CFP
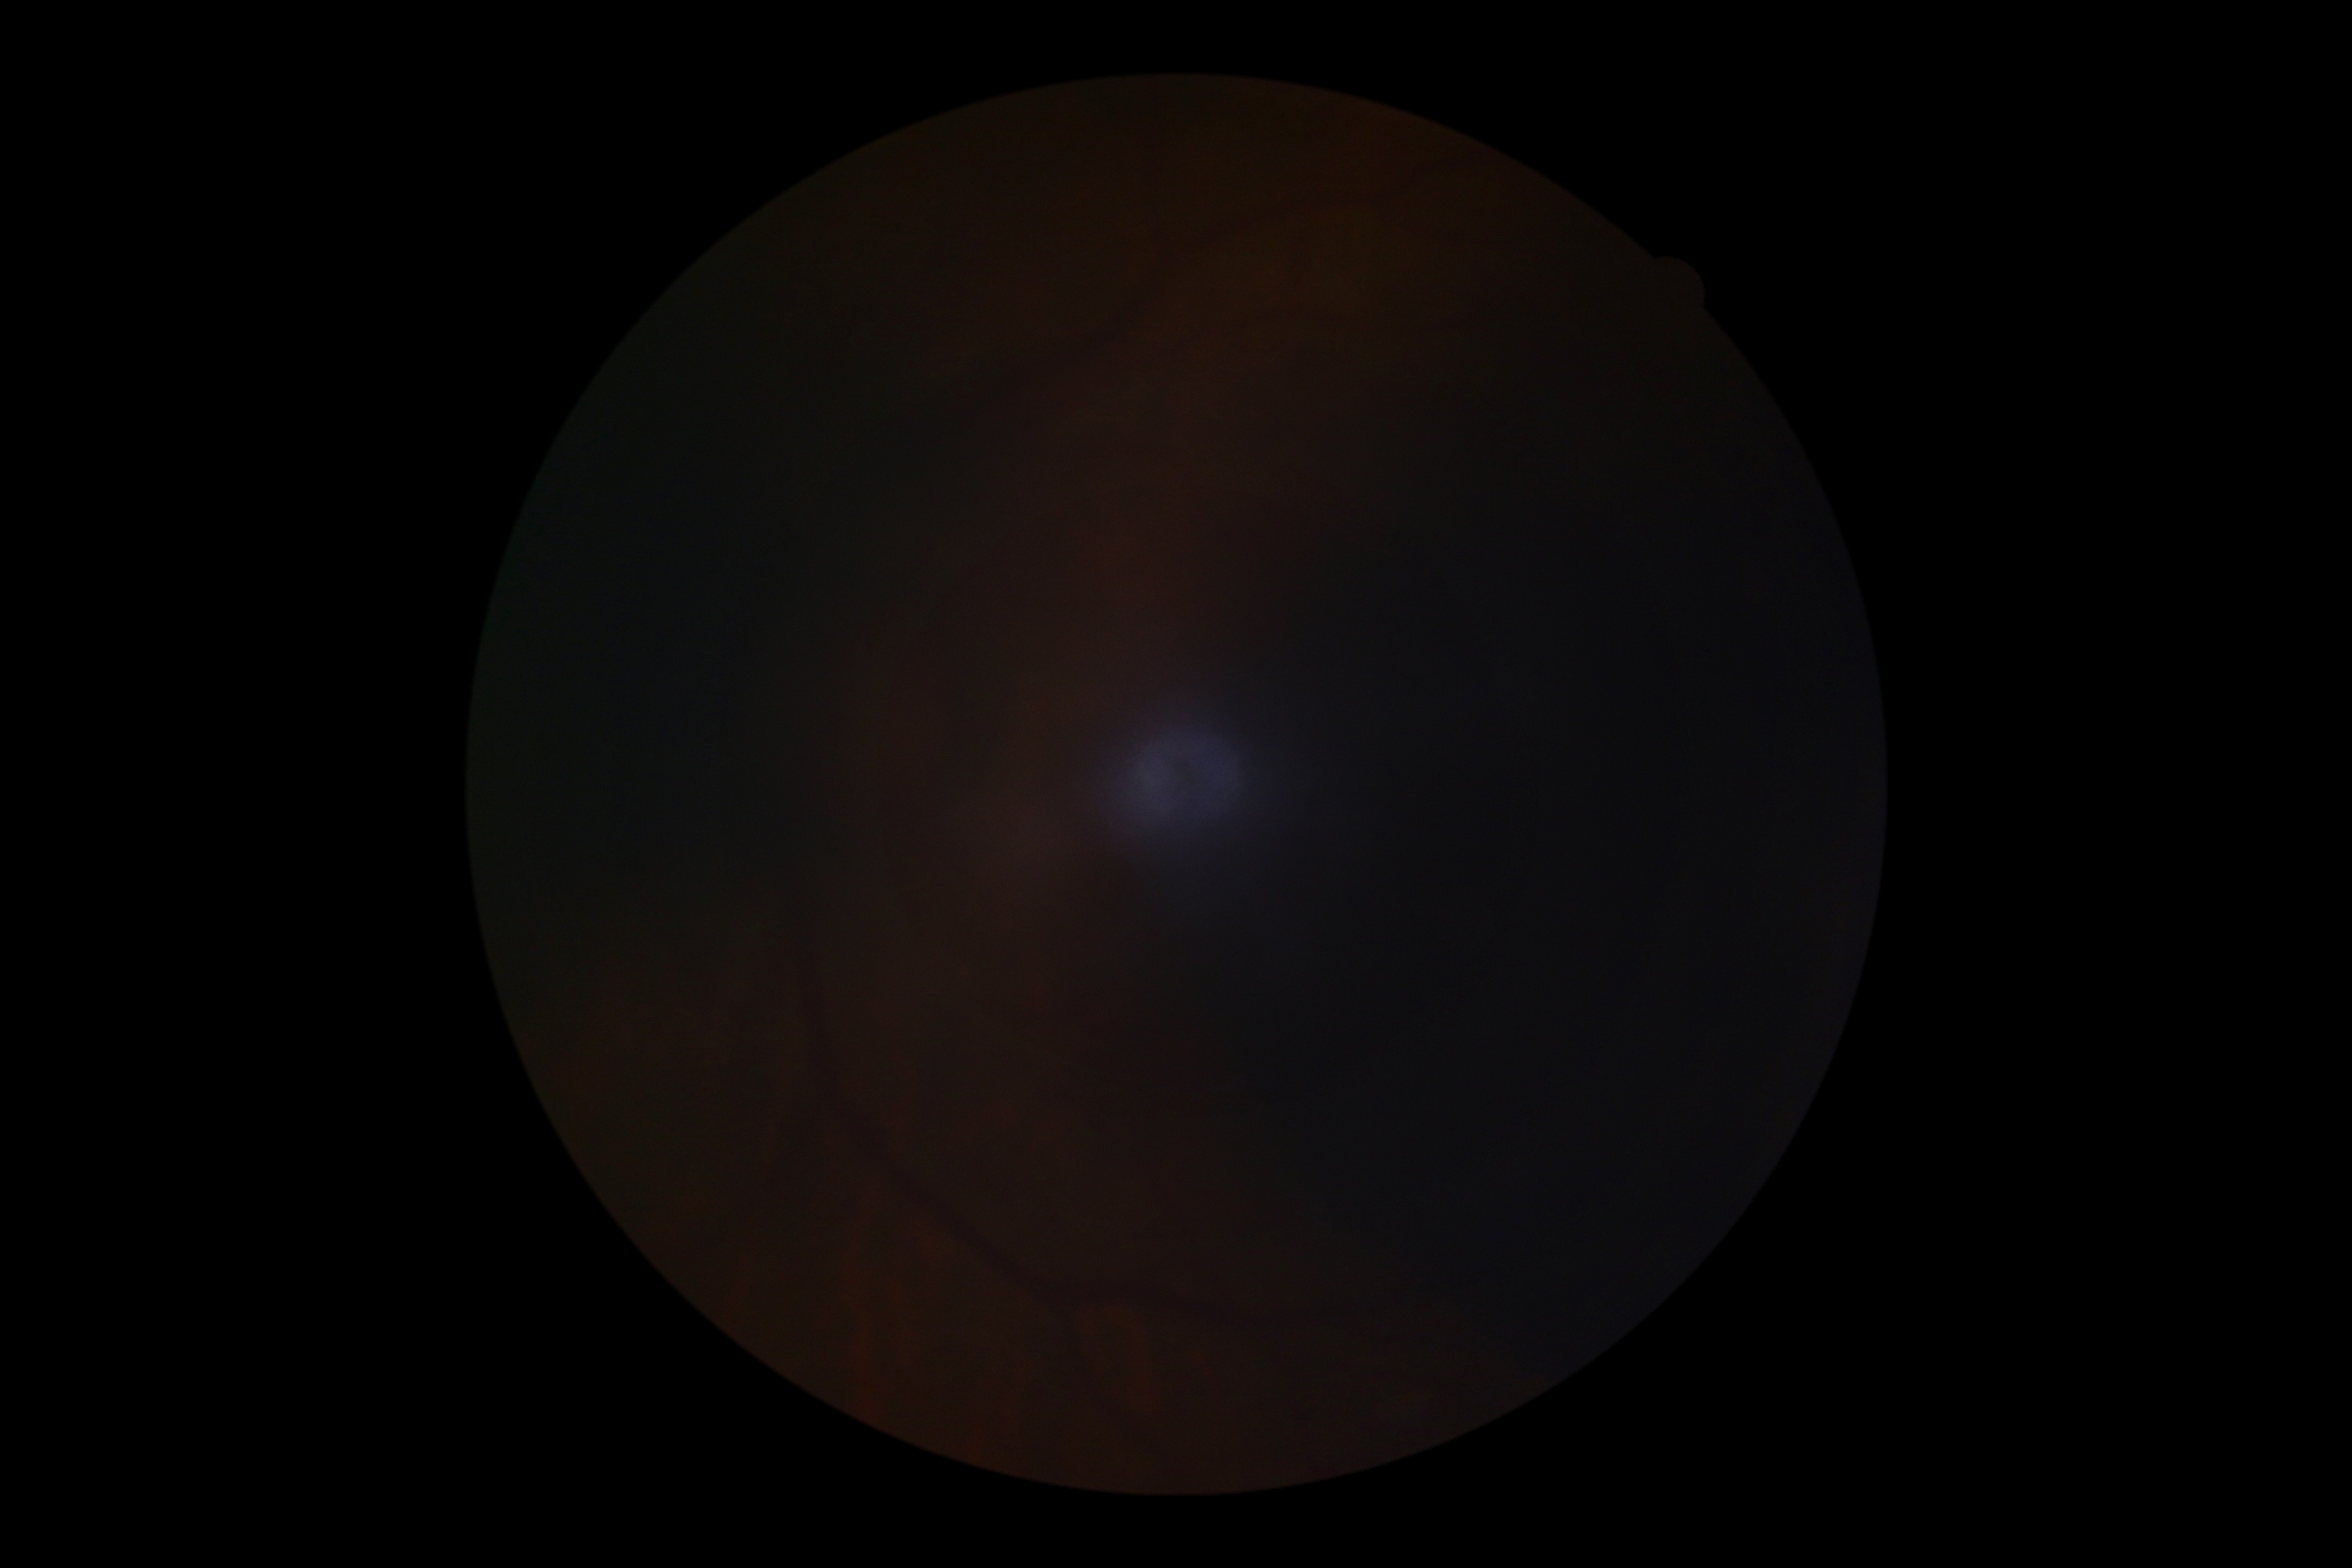 Ungradable image — DR severity cannot be determined.
DR: ungradable.